Fundus photo
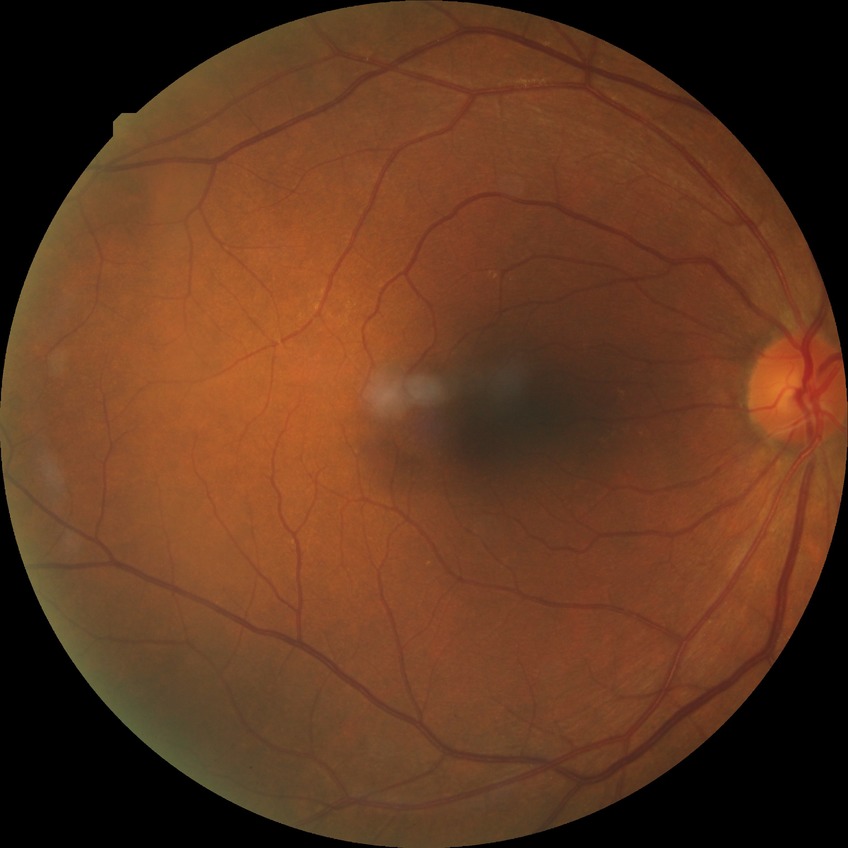
retinopathy stage@no diabetic retinopathy.